1924x1556, color fundus image: 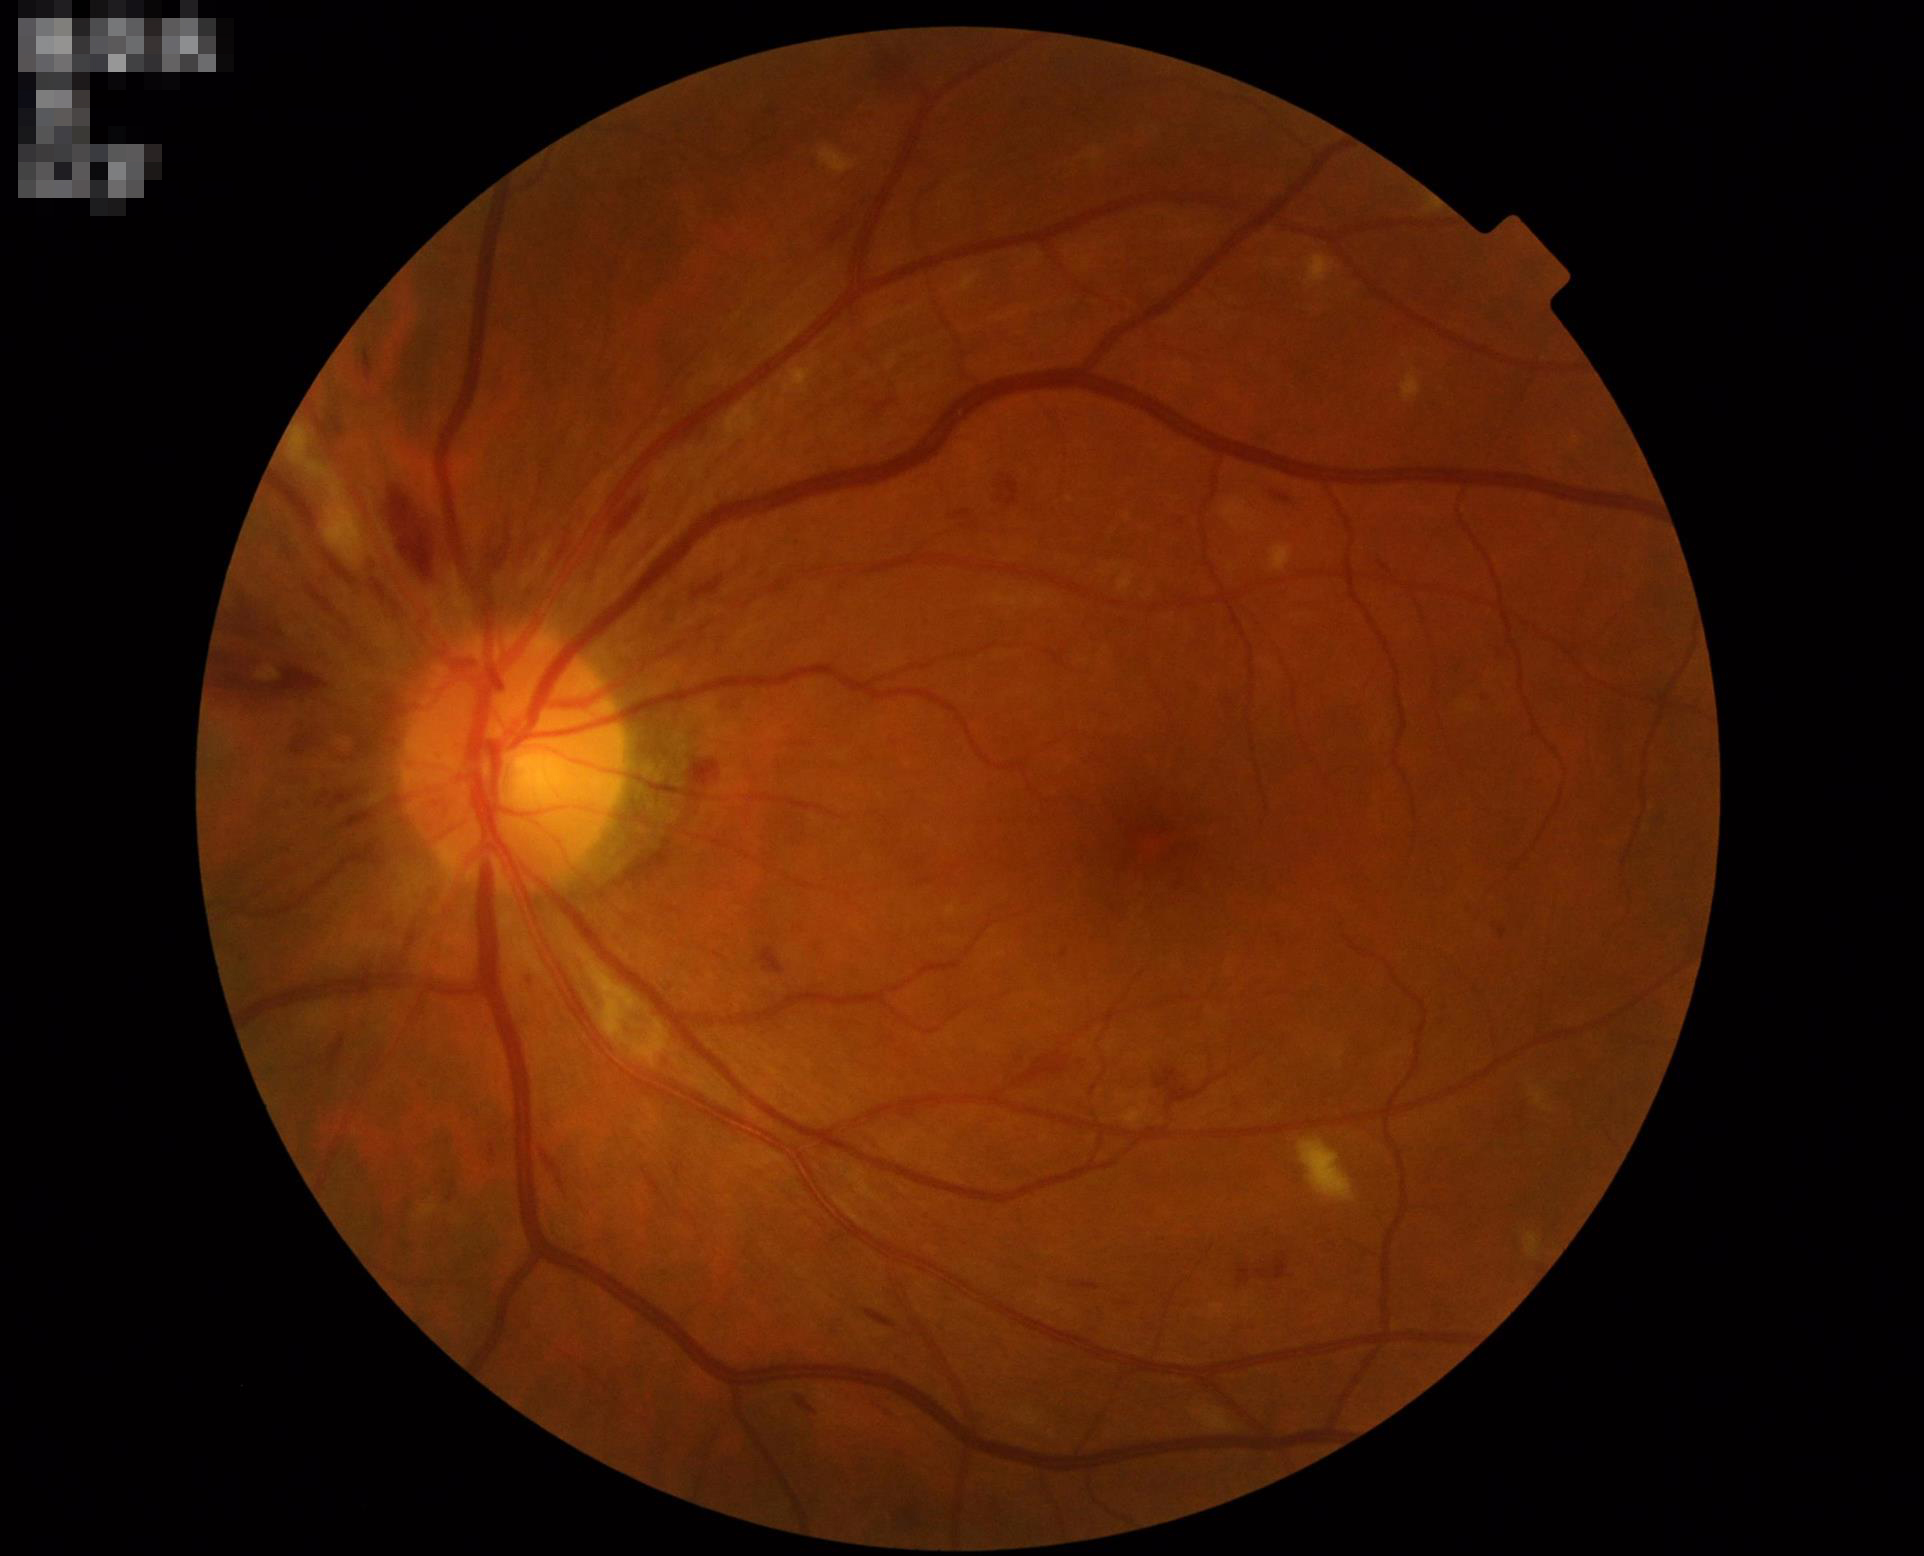   clarity: clear
  illumination: even
  overall_quality: acceptable
  contrast: good